Infant wide-field retinal image · 640 by 480 pixels: 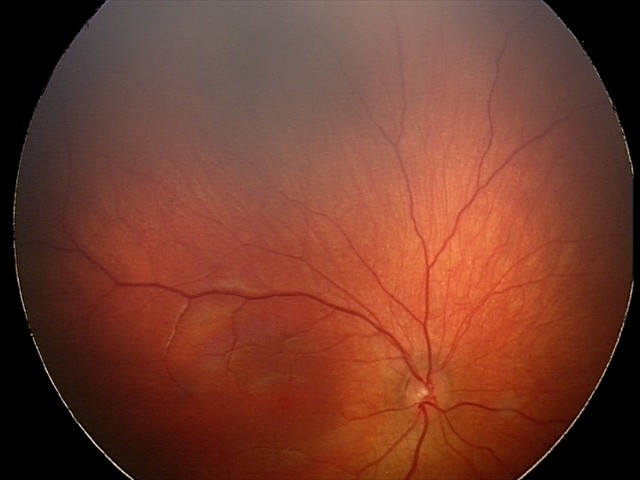

Diagnosis from this screening exam: retinal hemorrhages.